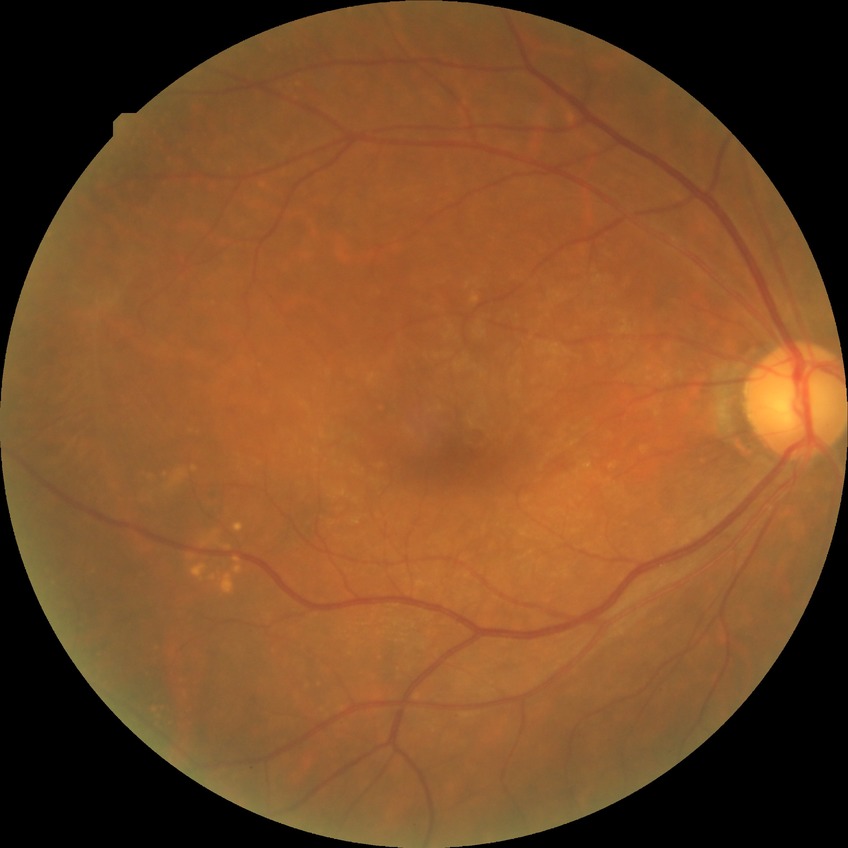

Diabetic retinopathy (DR) is NDR (no diabetic retinopathy).